Graded on the modified Davis scale, image size 848x848, camera: NIDEK AFC-230 — 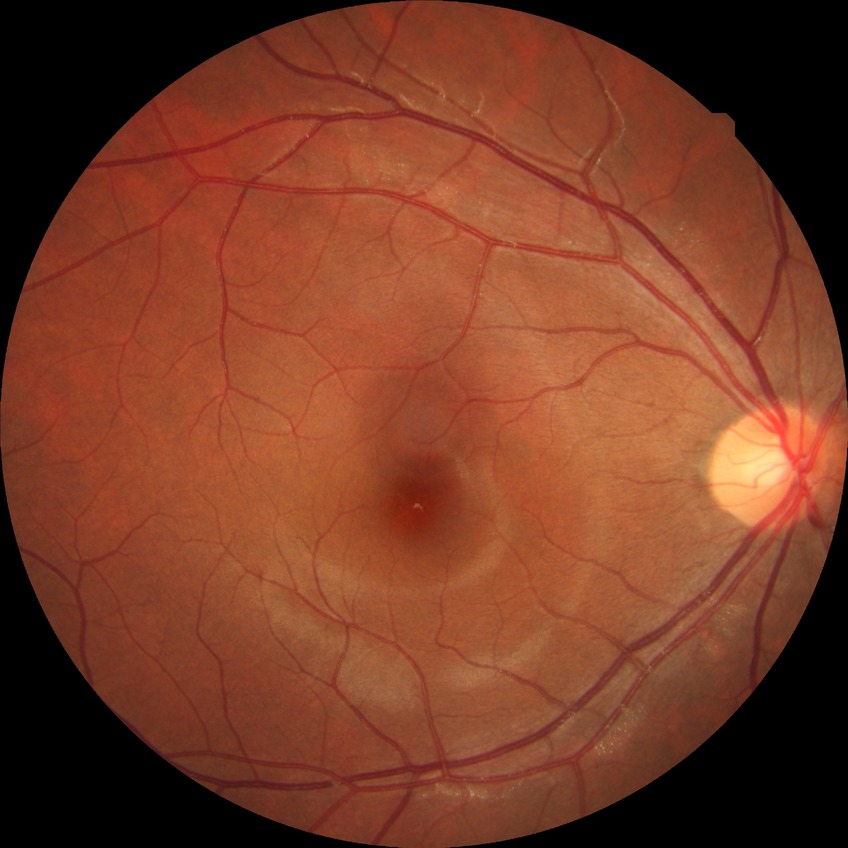

Diabetic retinopathy (DR): NDR (no diabetic retinopathy).